CFP:
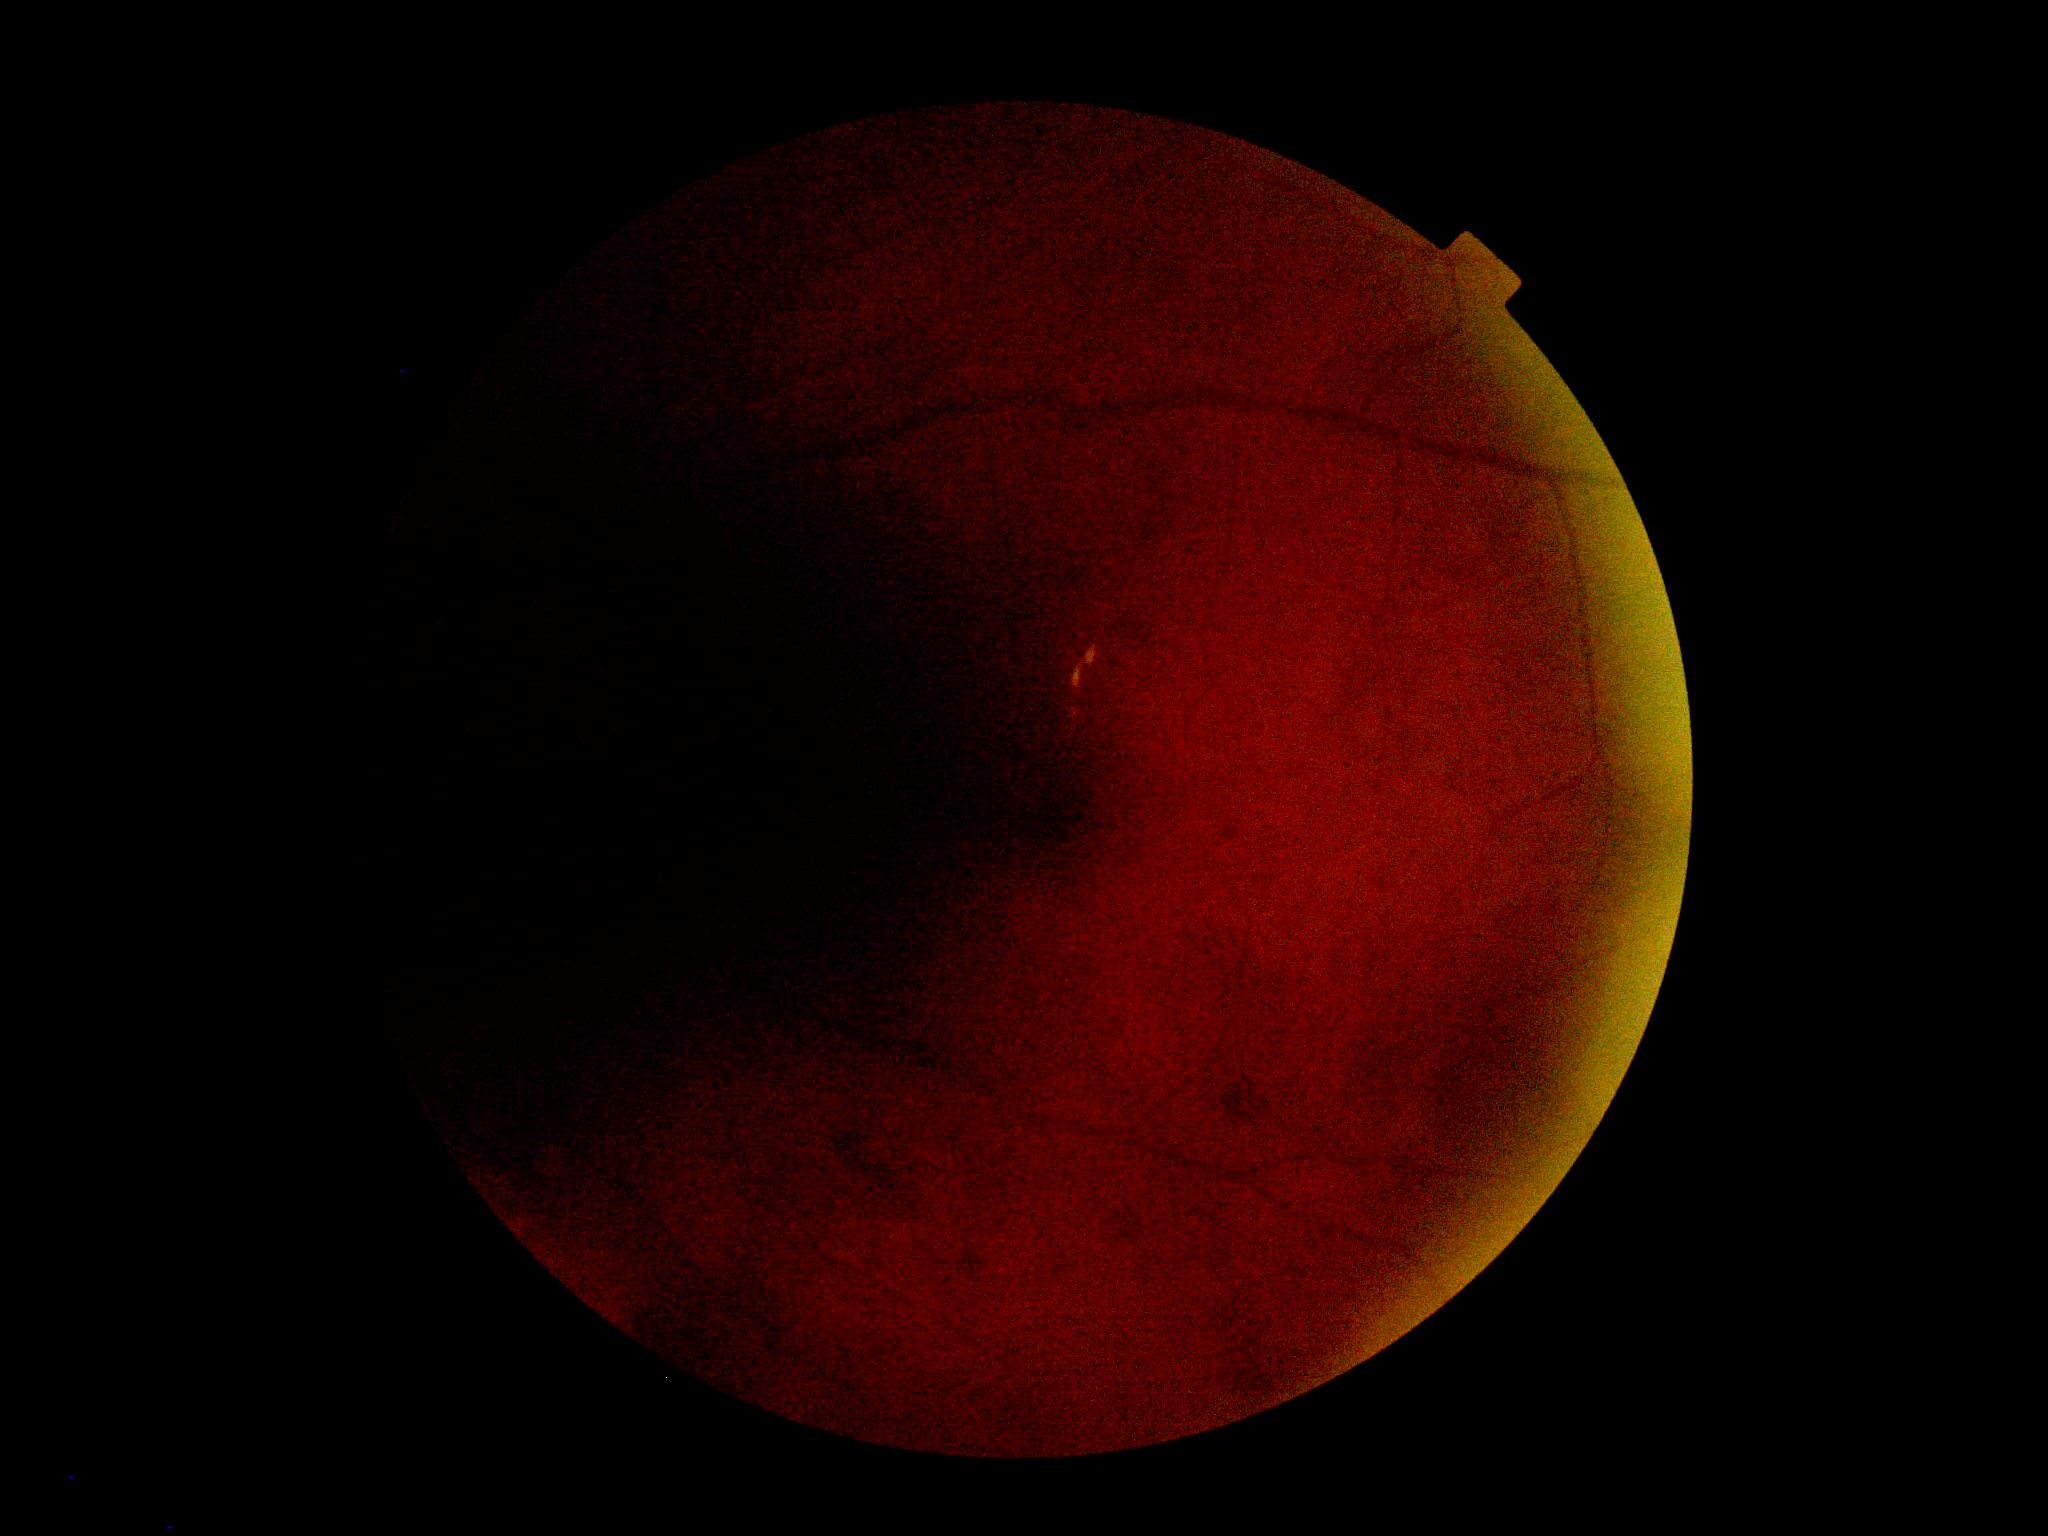

DR class = non-proliferative diabetic retinopathy
diabetic retinopathy (DR) = grade 2 (moderate NPDR)